Color fundus image
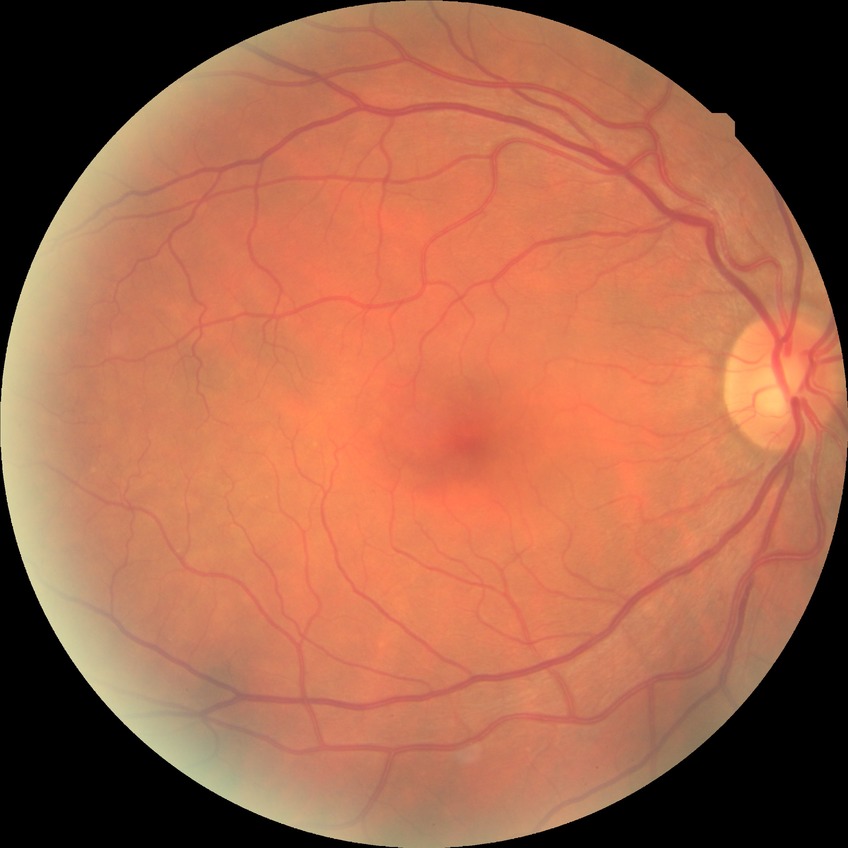
Davis stage=NDR.